CFP · 2352 by 1568 pixels:
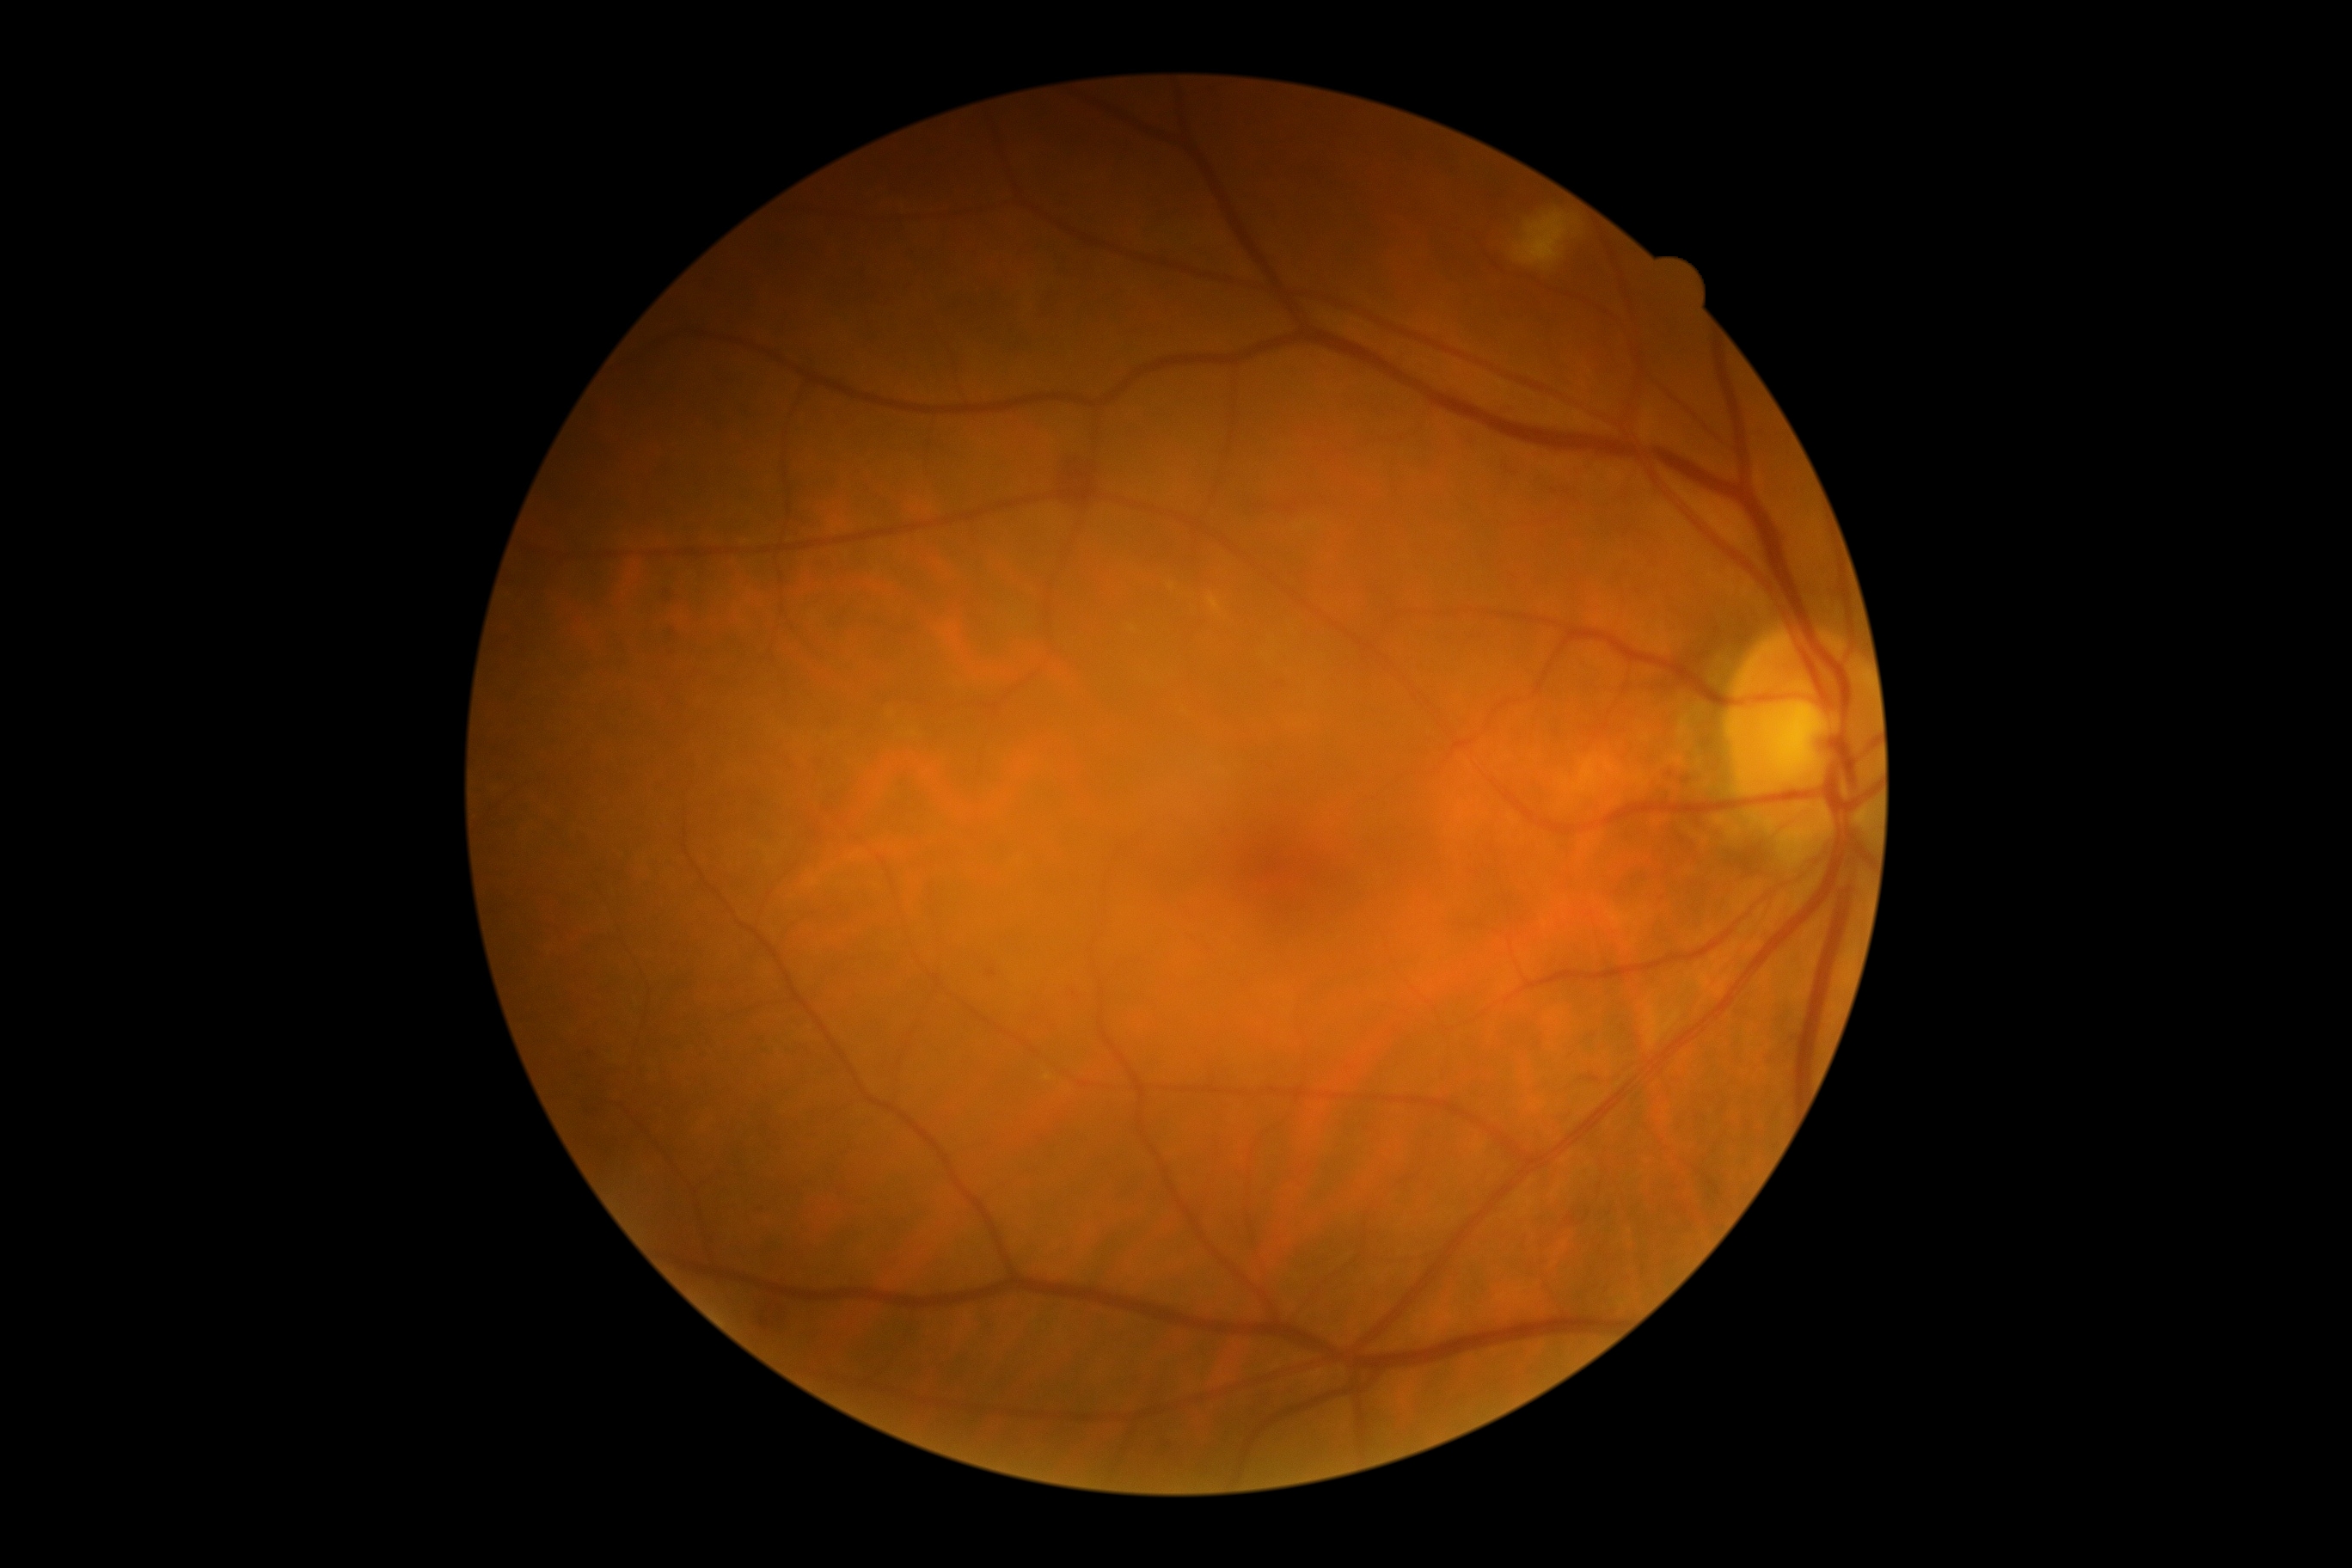

DR: grade 2 (moderate NPDR).